Color fundus photograph. Topcon TRC-50DX:
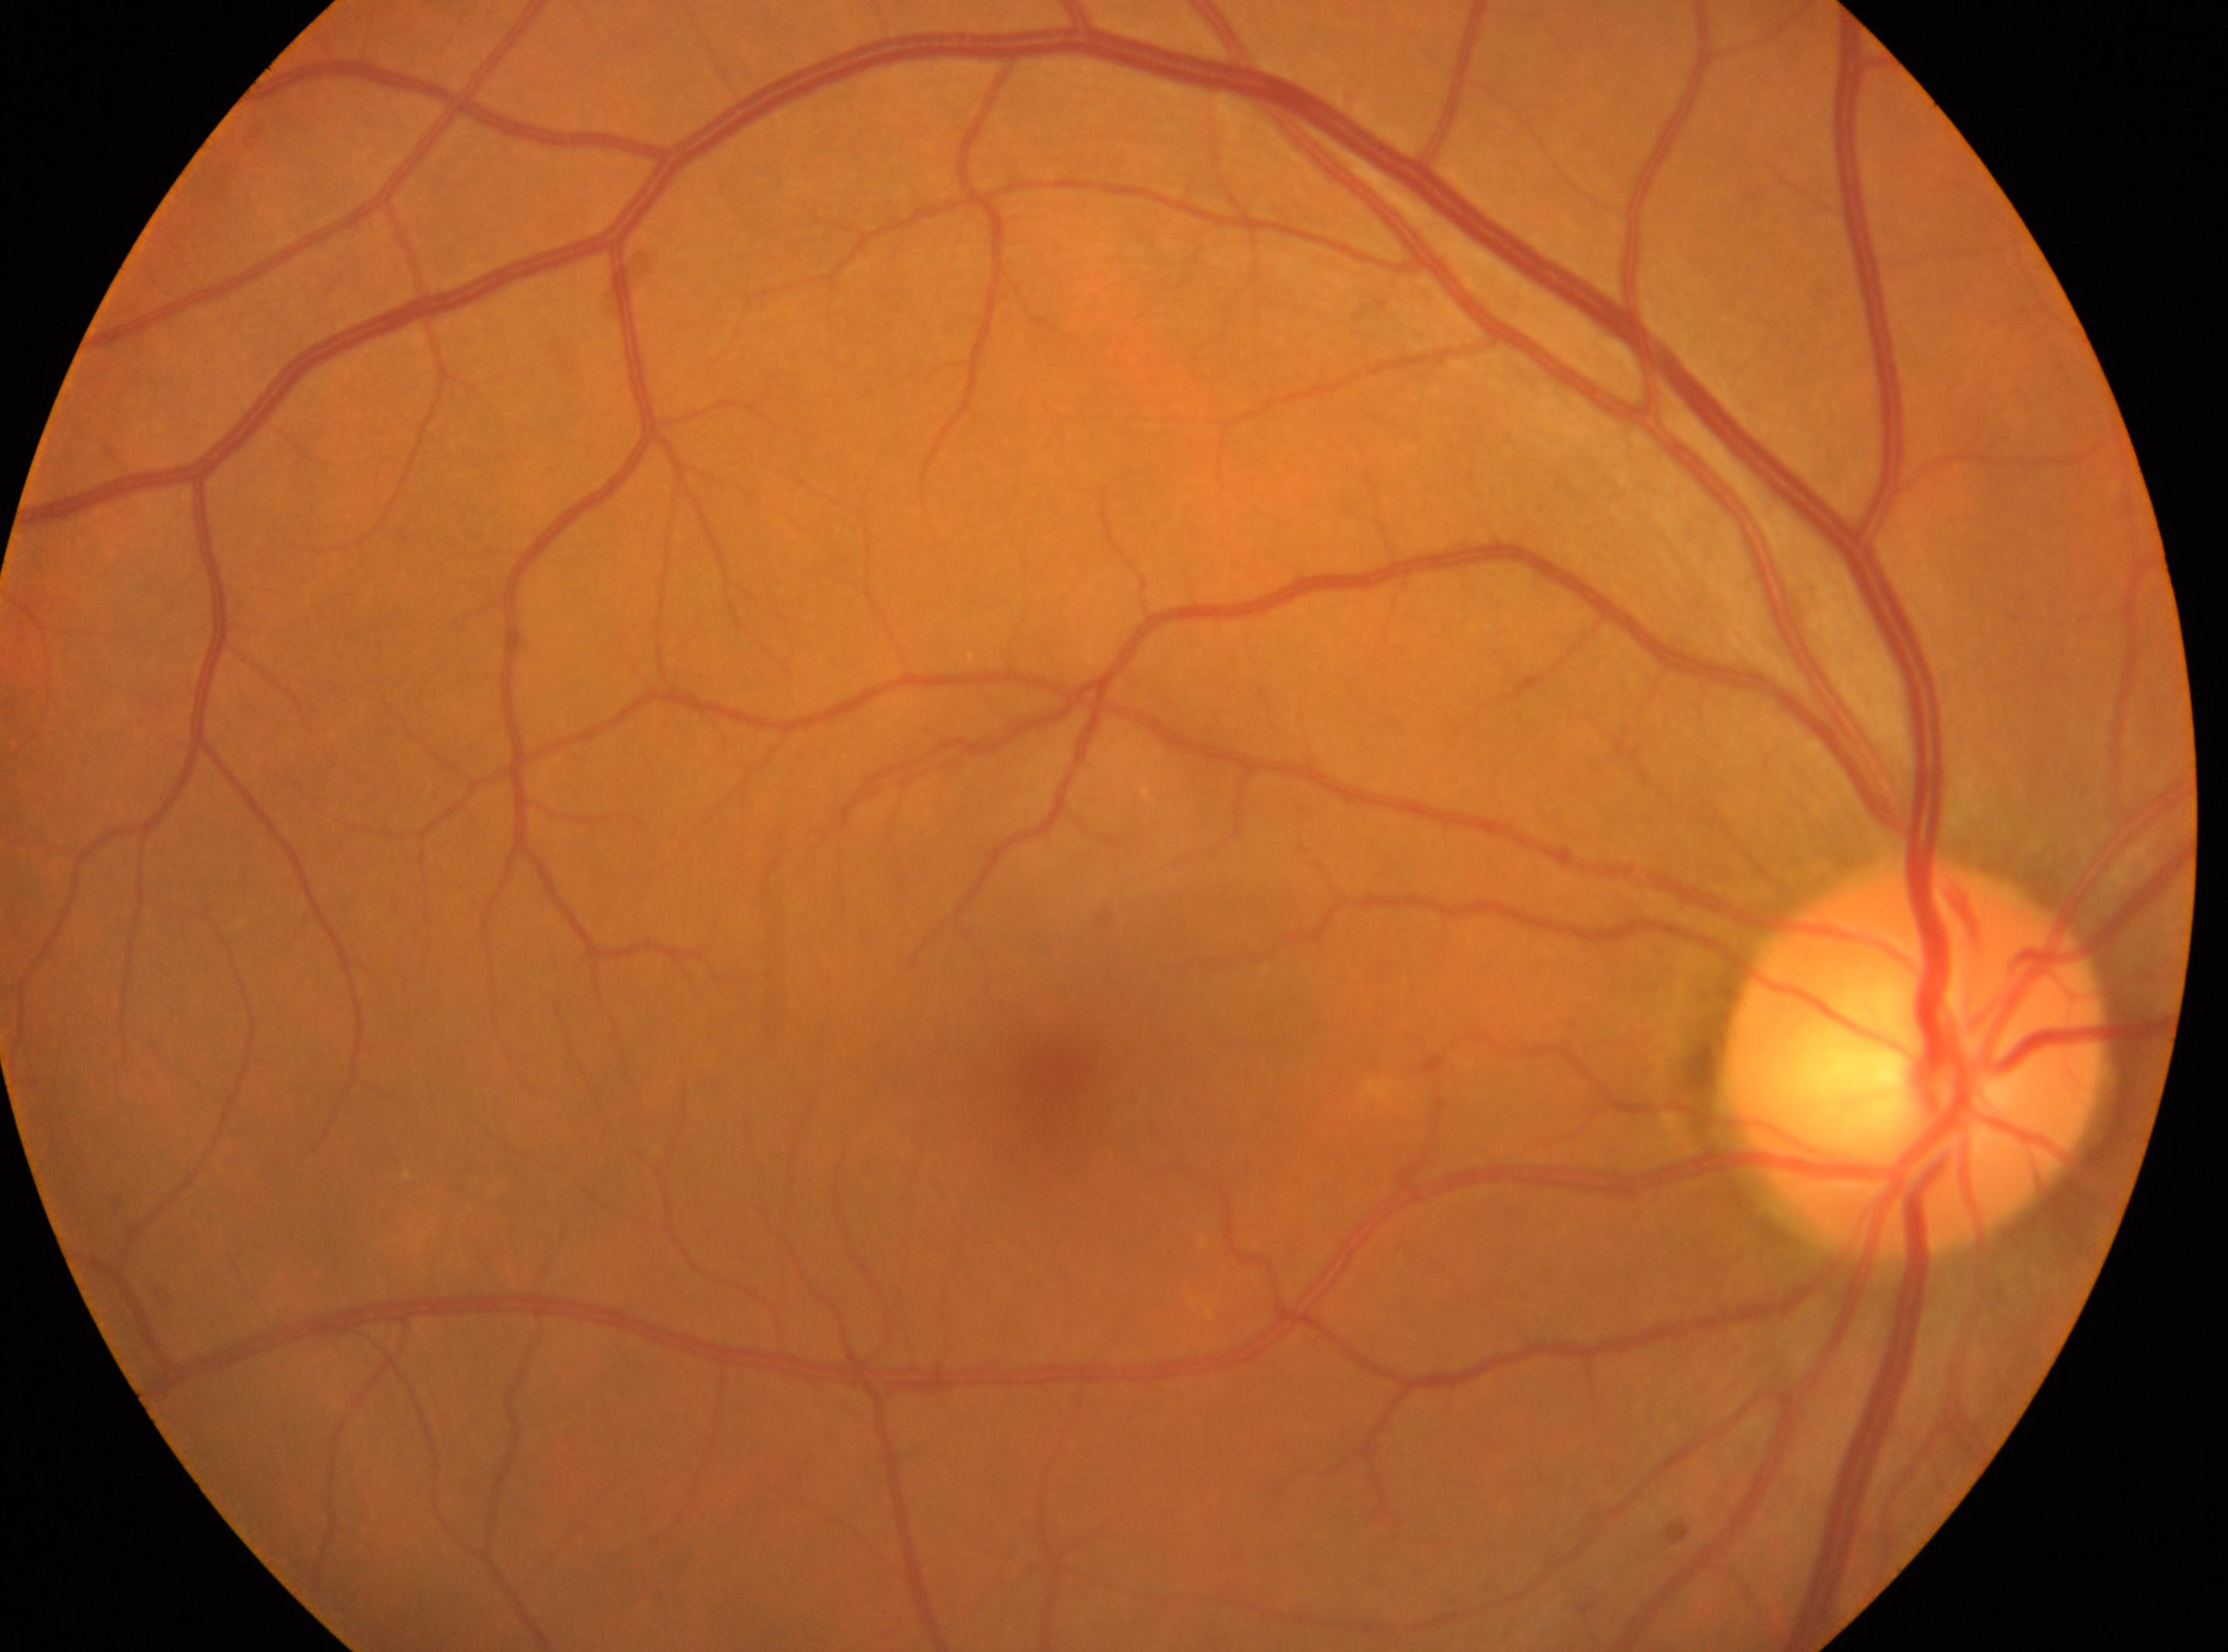

Findings:
– diabetic retinopathy severity · grade 0 (no apparent retinopathy)
– DR impression · No diabetic retinopathy identified
– eye · OD
– optic disk · [1915, 1056]
– macular center · [1063, 1075]